Pediatric wide-field fundus photograph. Image size 1240x1240: 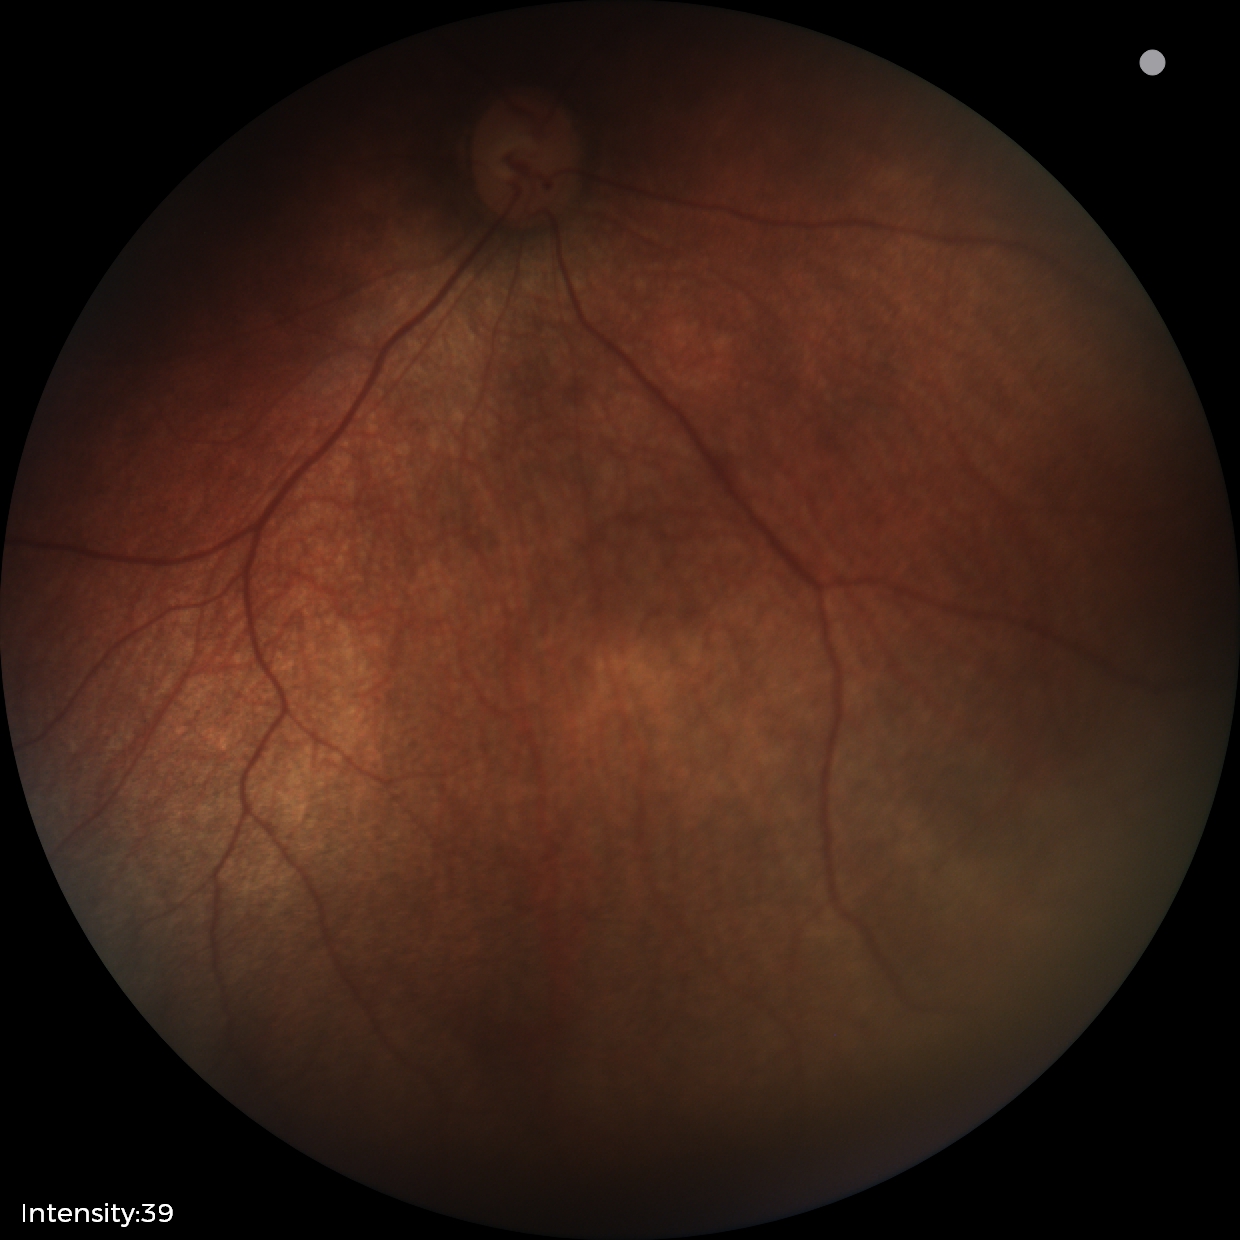
Assessment: physiological retinal finding.